Macula-centered, fundus photo, FOV: 50 degrees
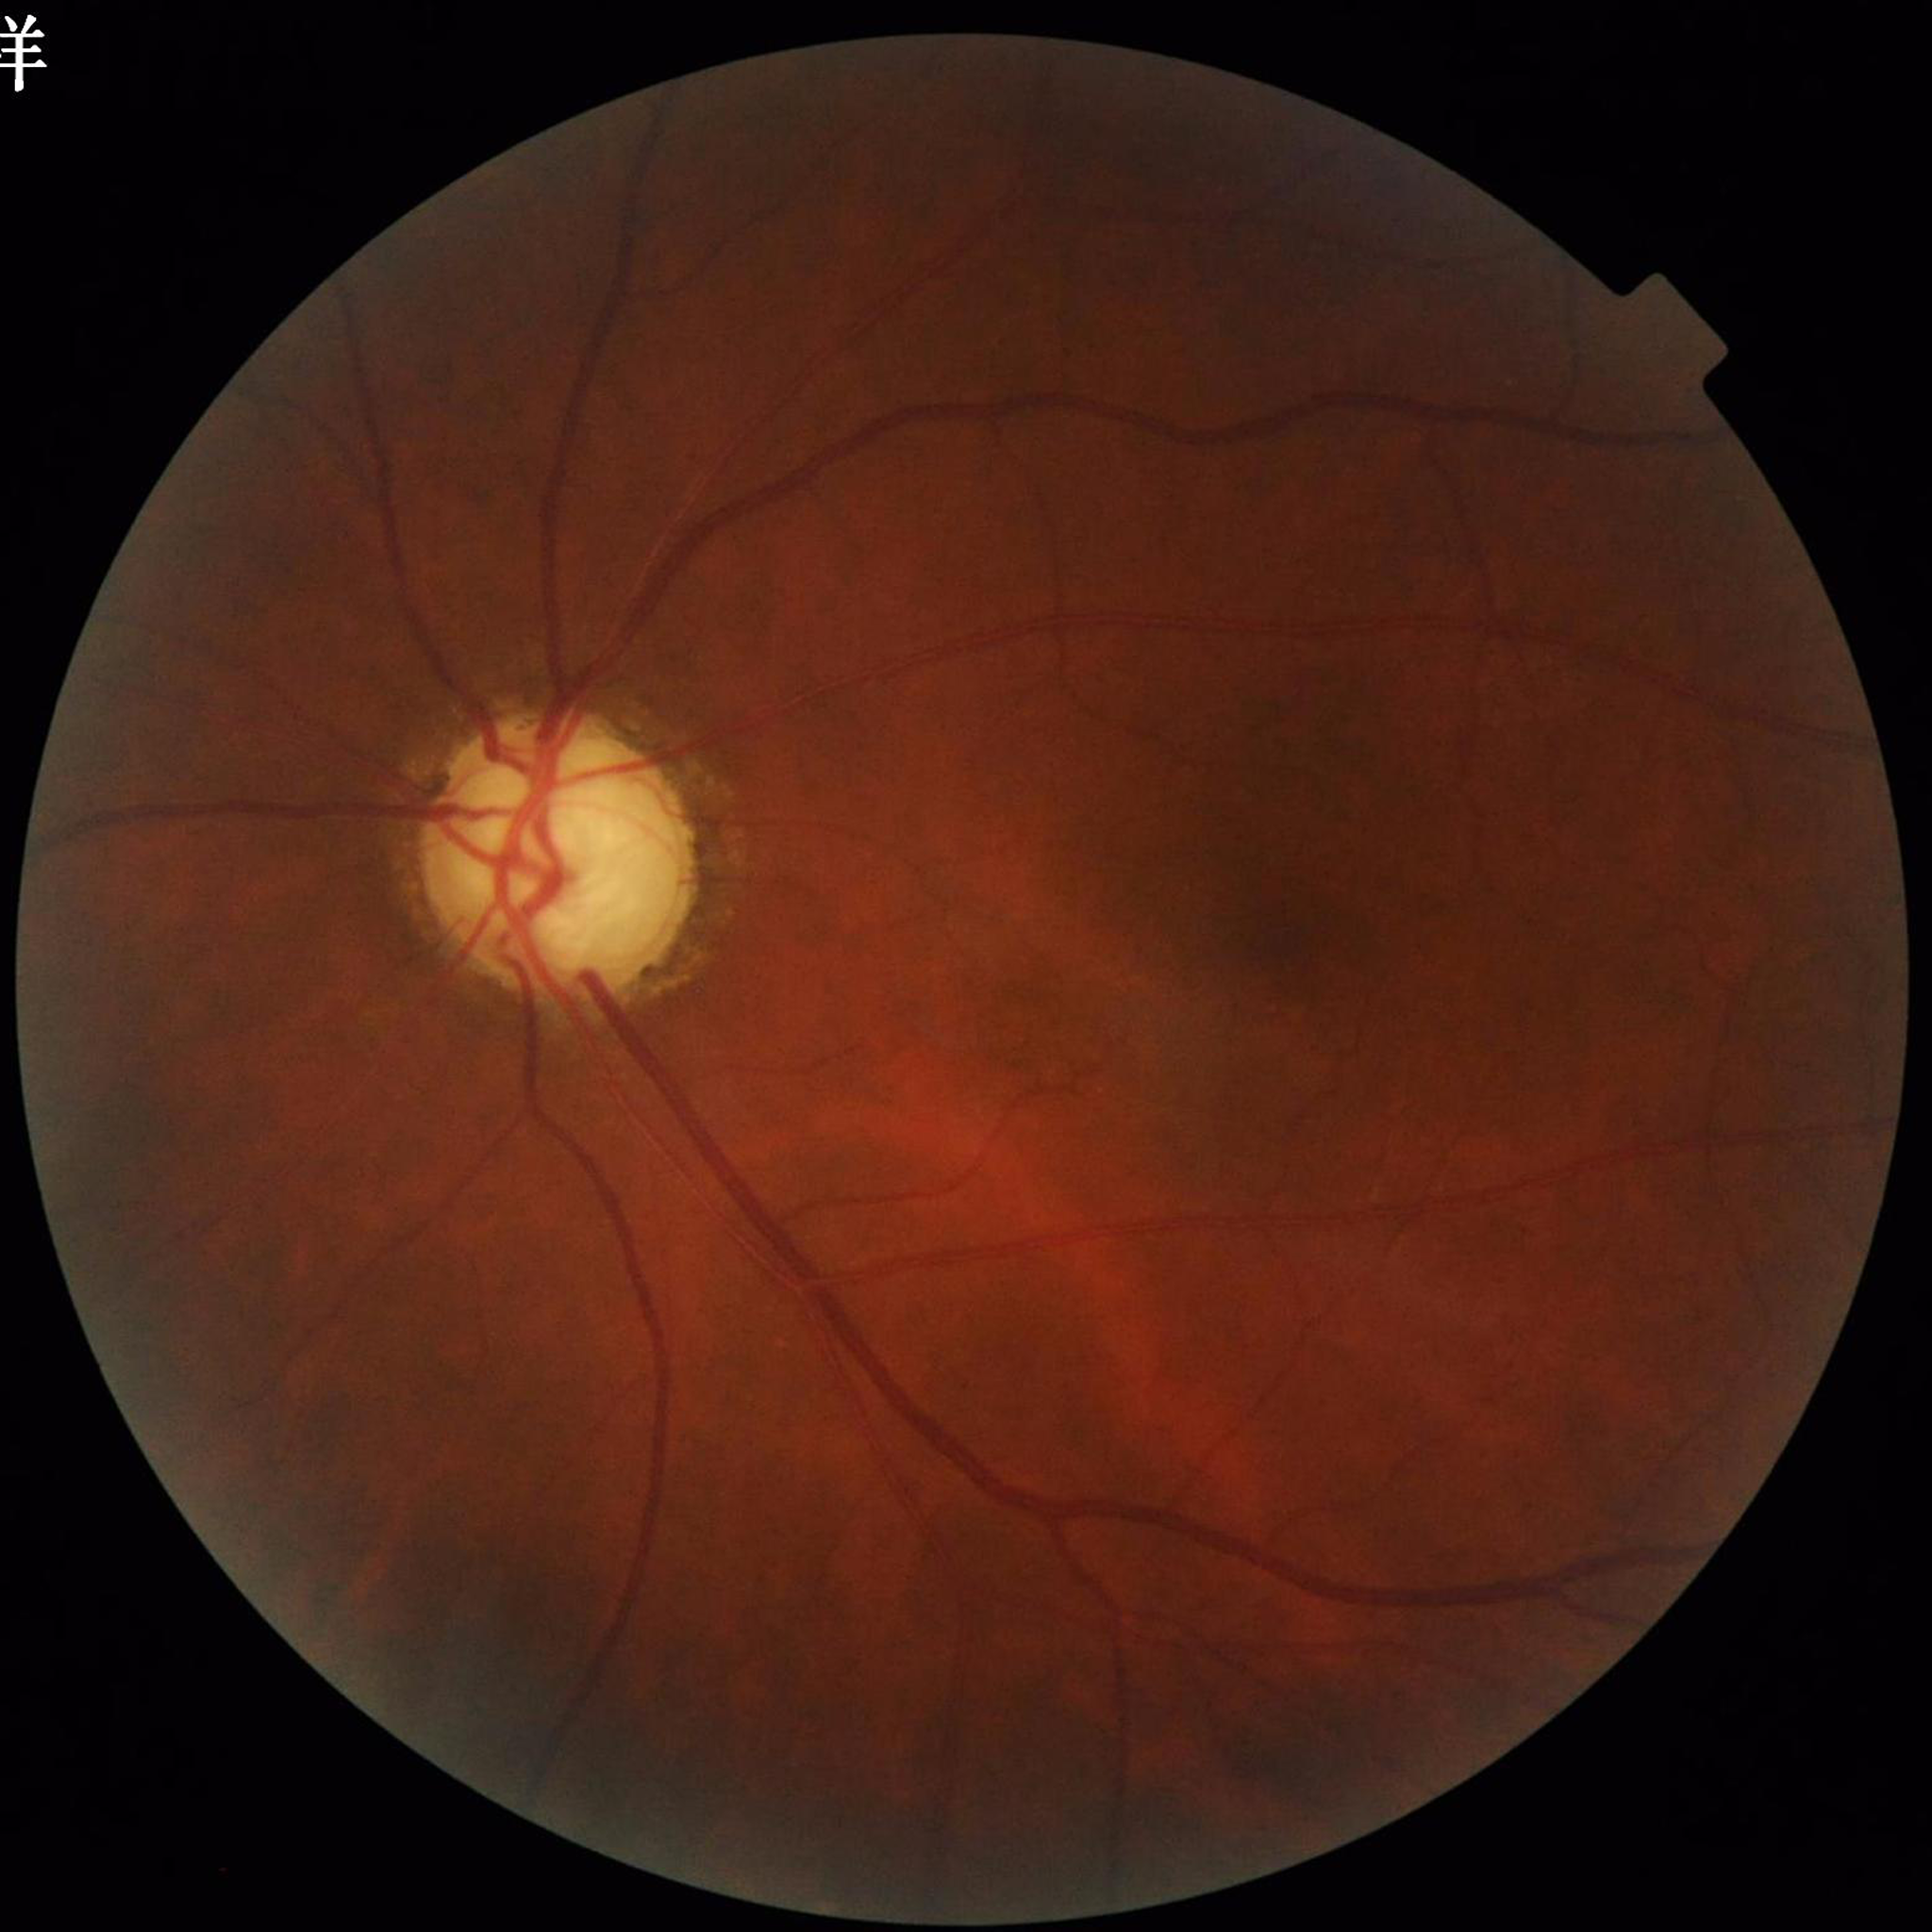
Diagnosed with glaucoma.